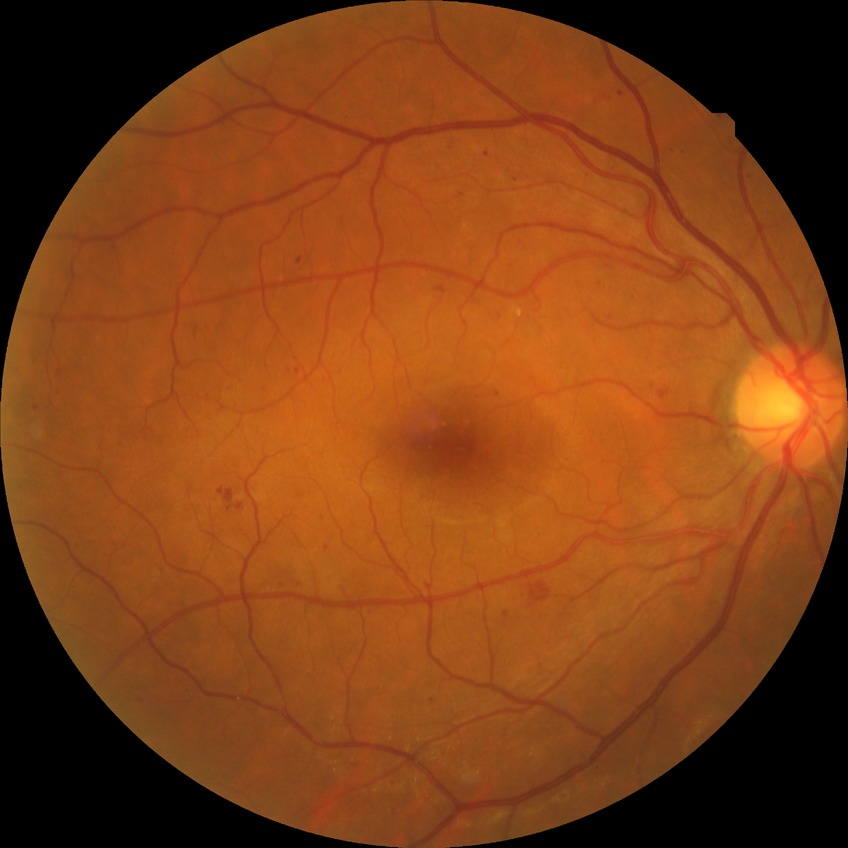 diabetic retinopathy (DR) = simple diabetic retinopathy (SDR).